Infant wide-field fundus photograph: 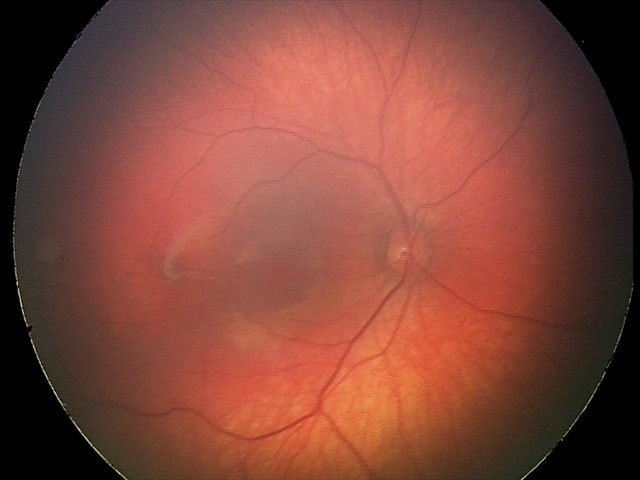

Diagnosis from this screening exam: retinal hemorrhages.